45° field of view — 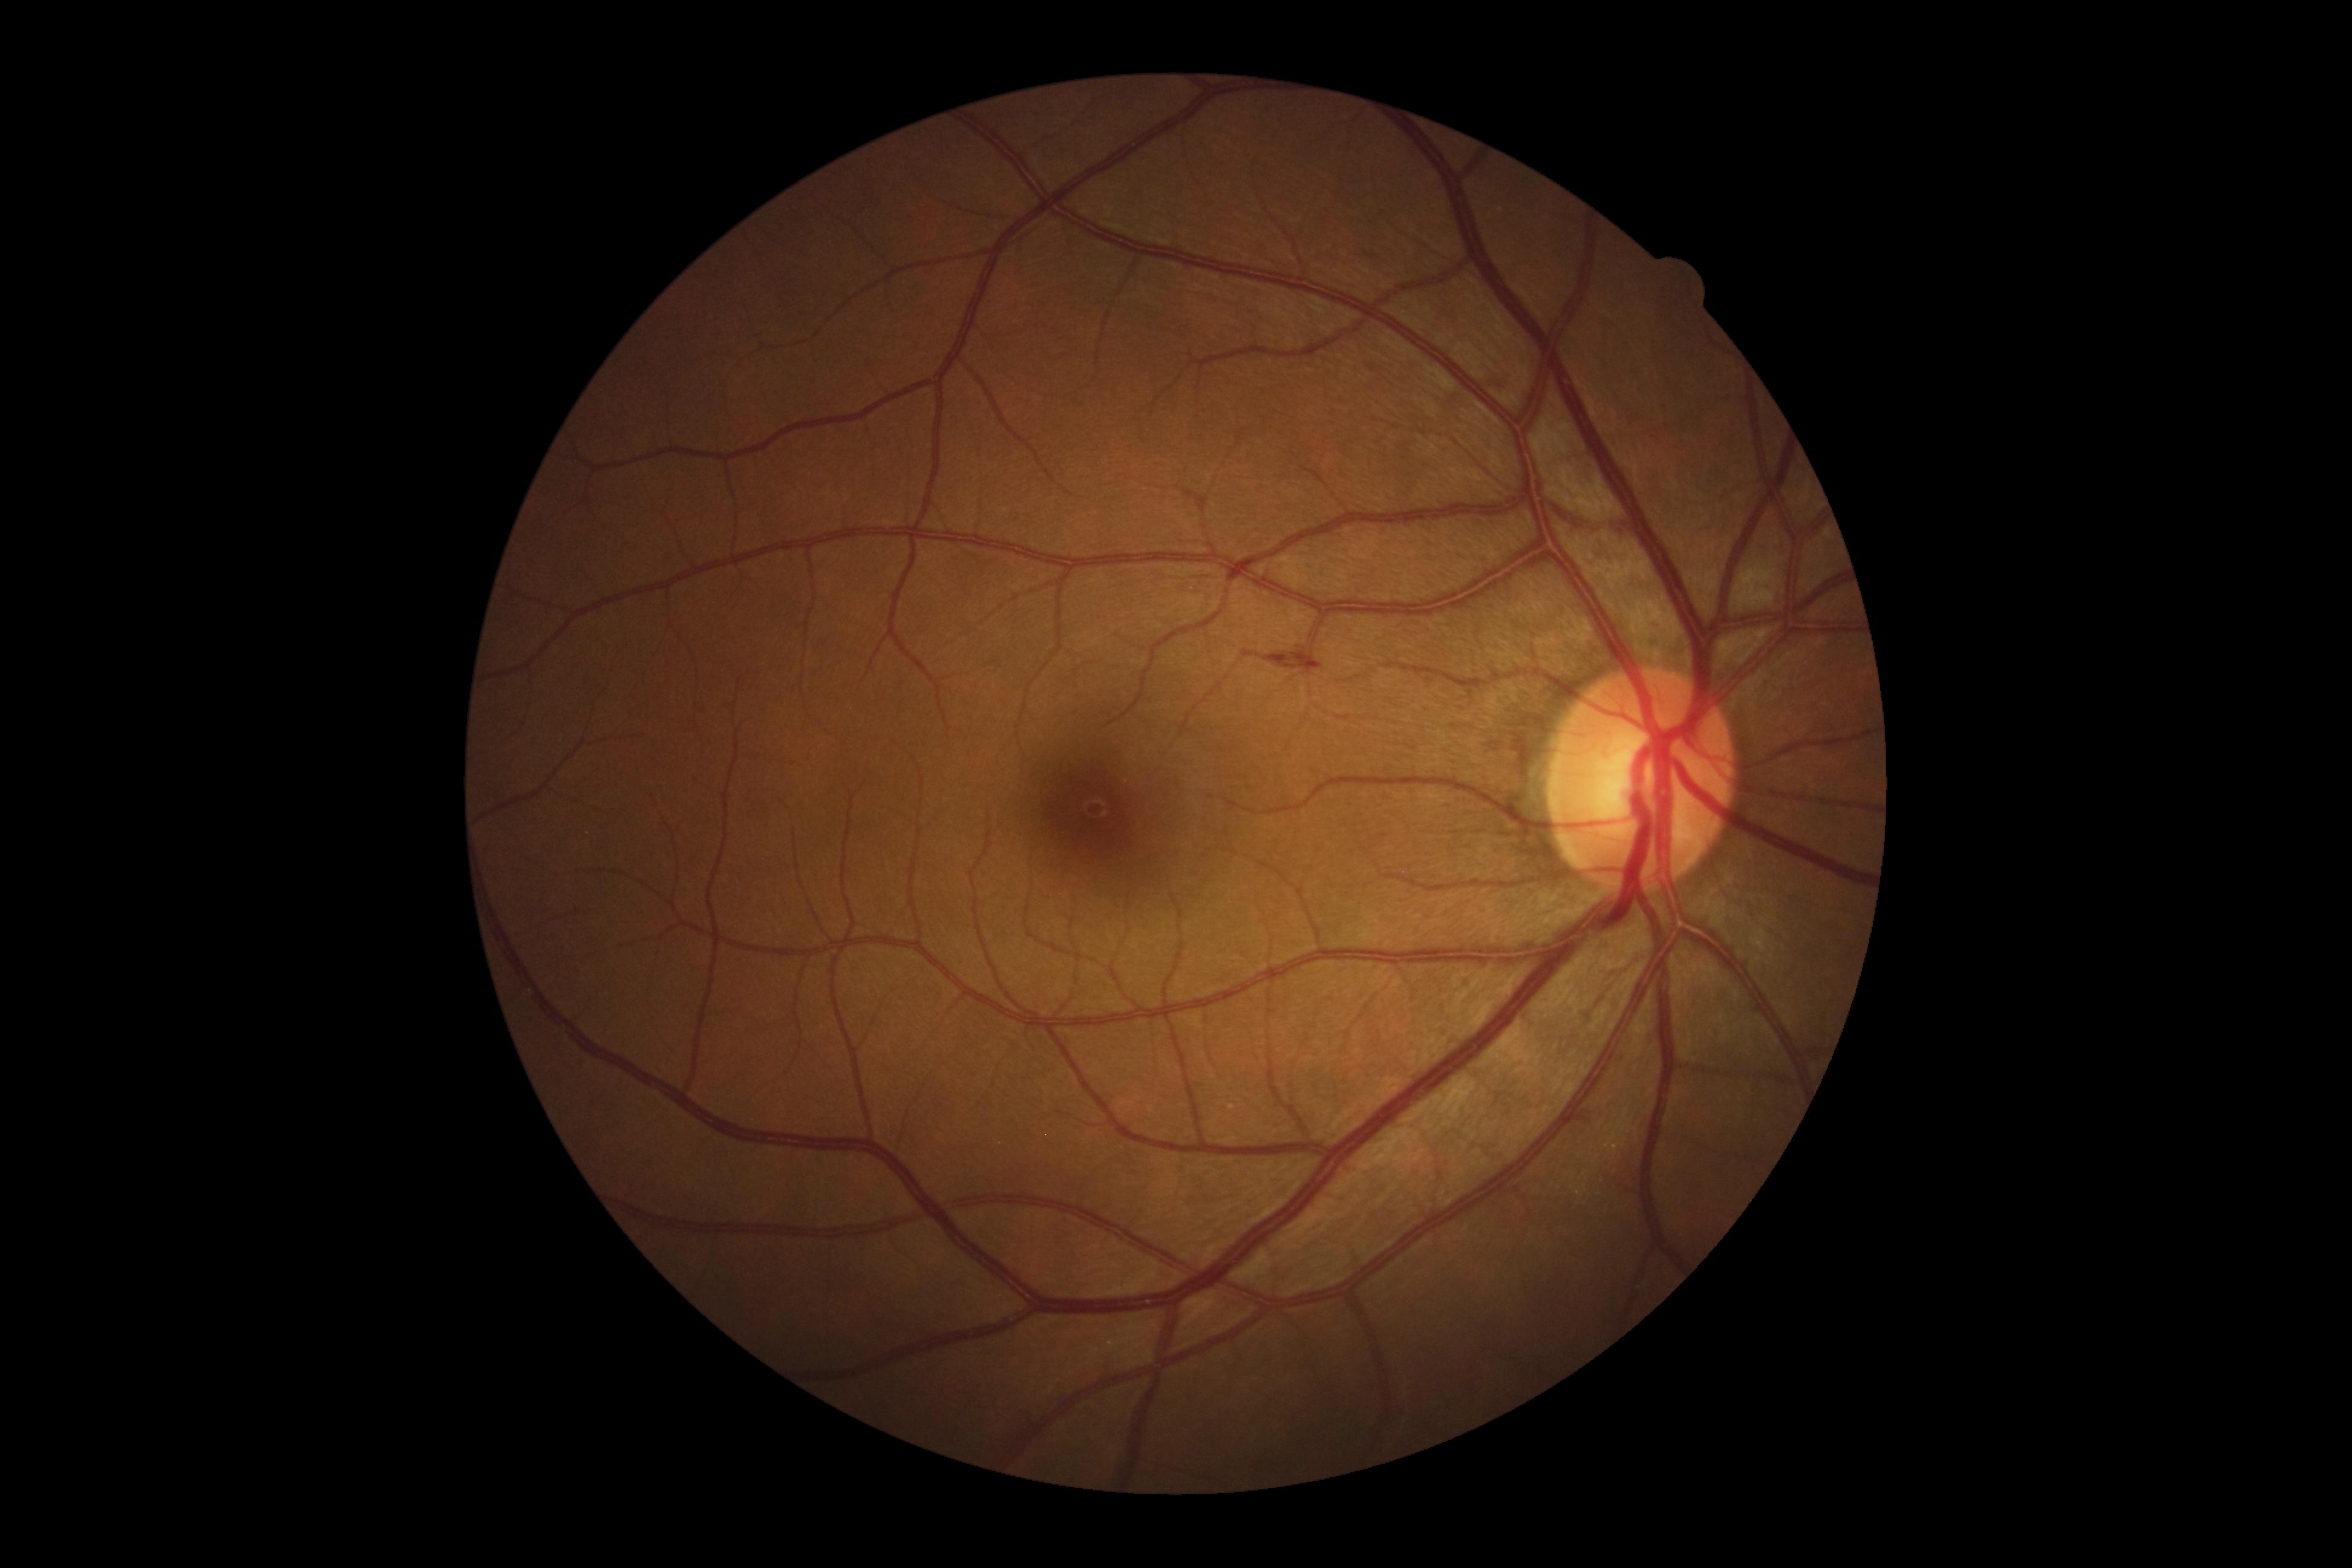
Disease class: non-proliferative diabetic retinopathy.
DR is grade 2 (moderate NPDR).